Image size 848x848; acquired with a NIDEK AFC-230; posterior pole photograph:
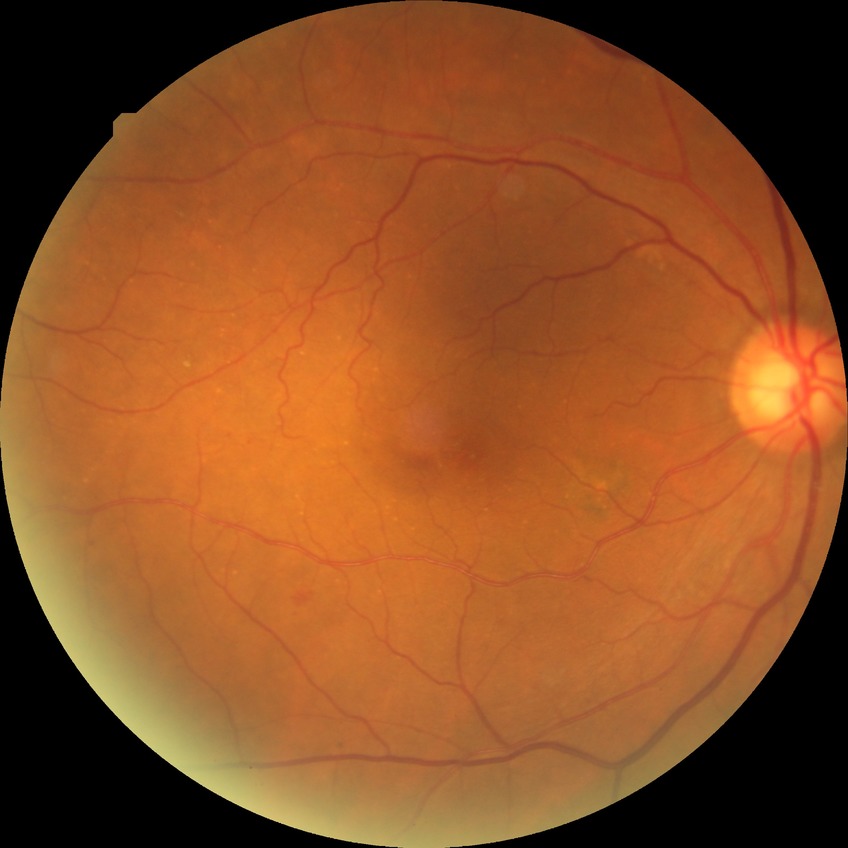

Modified Davis classification: simple diabetic retinopathy.